Optic disc-centered · intraocular pressure 25 mmHg (pneumatic tonometry) · patient age: 46 years · Topcon TRC-NW400 — 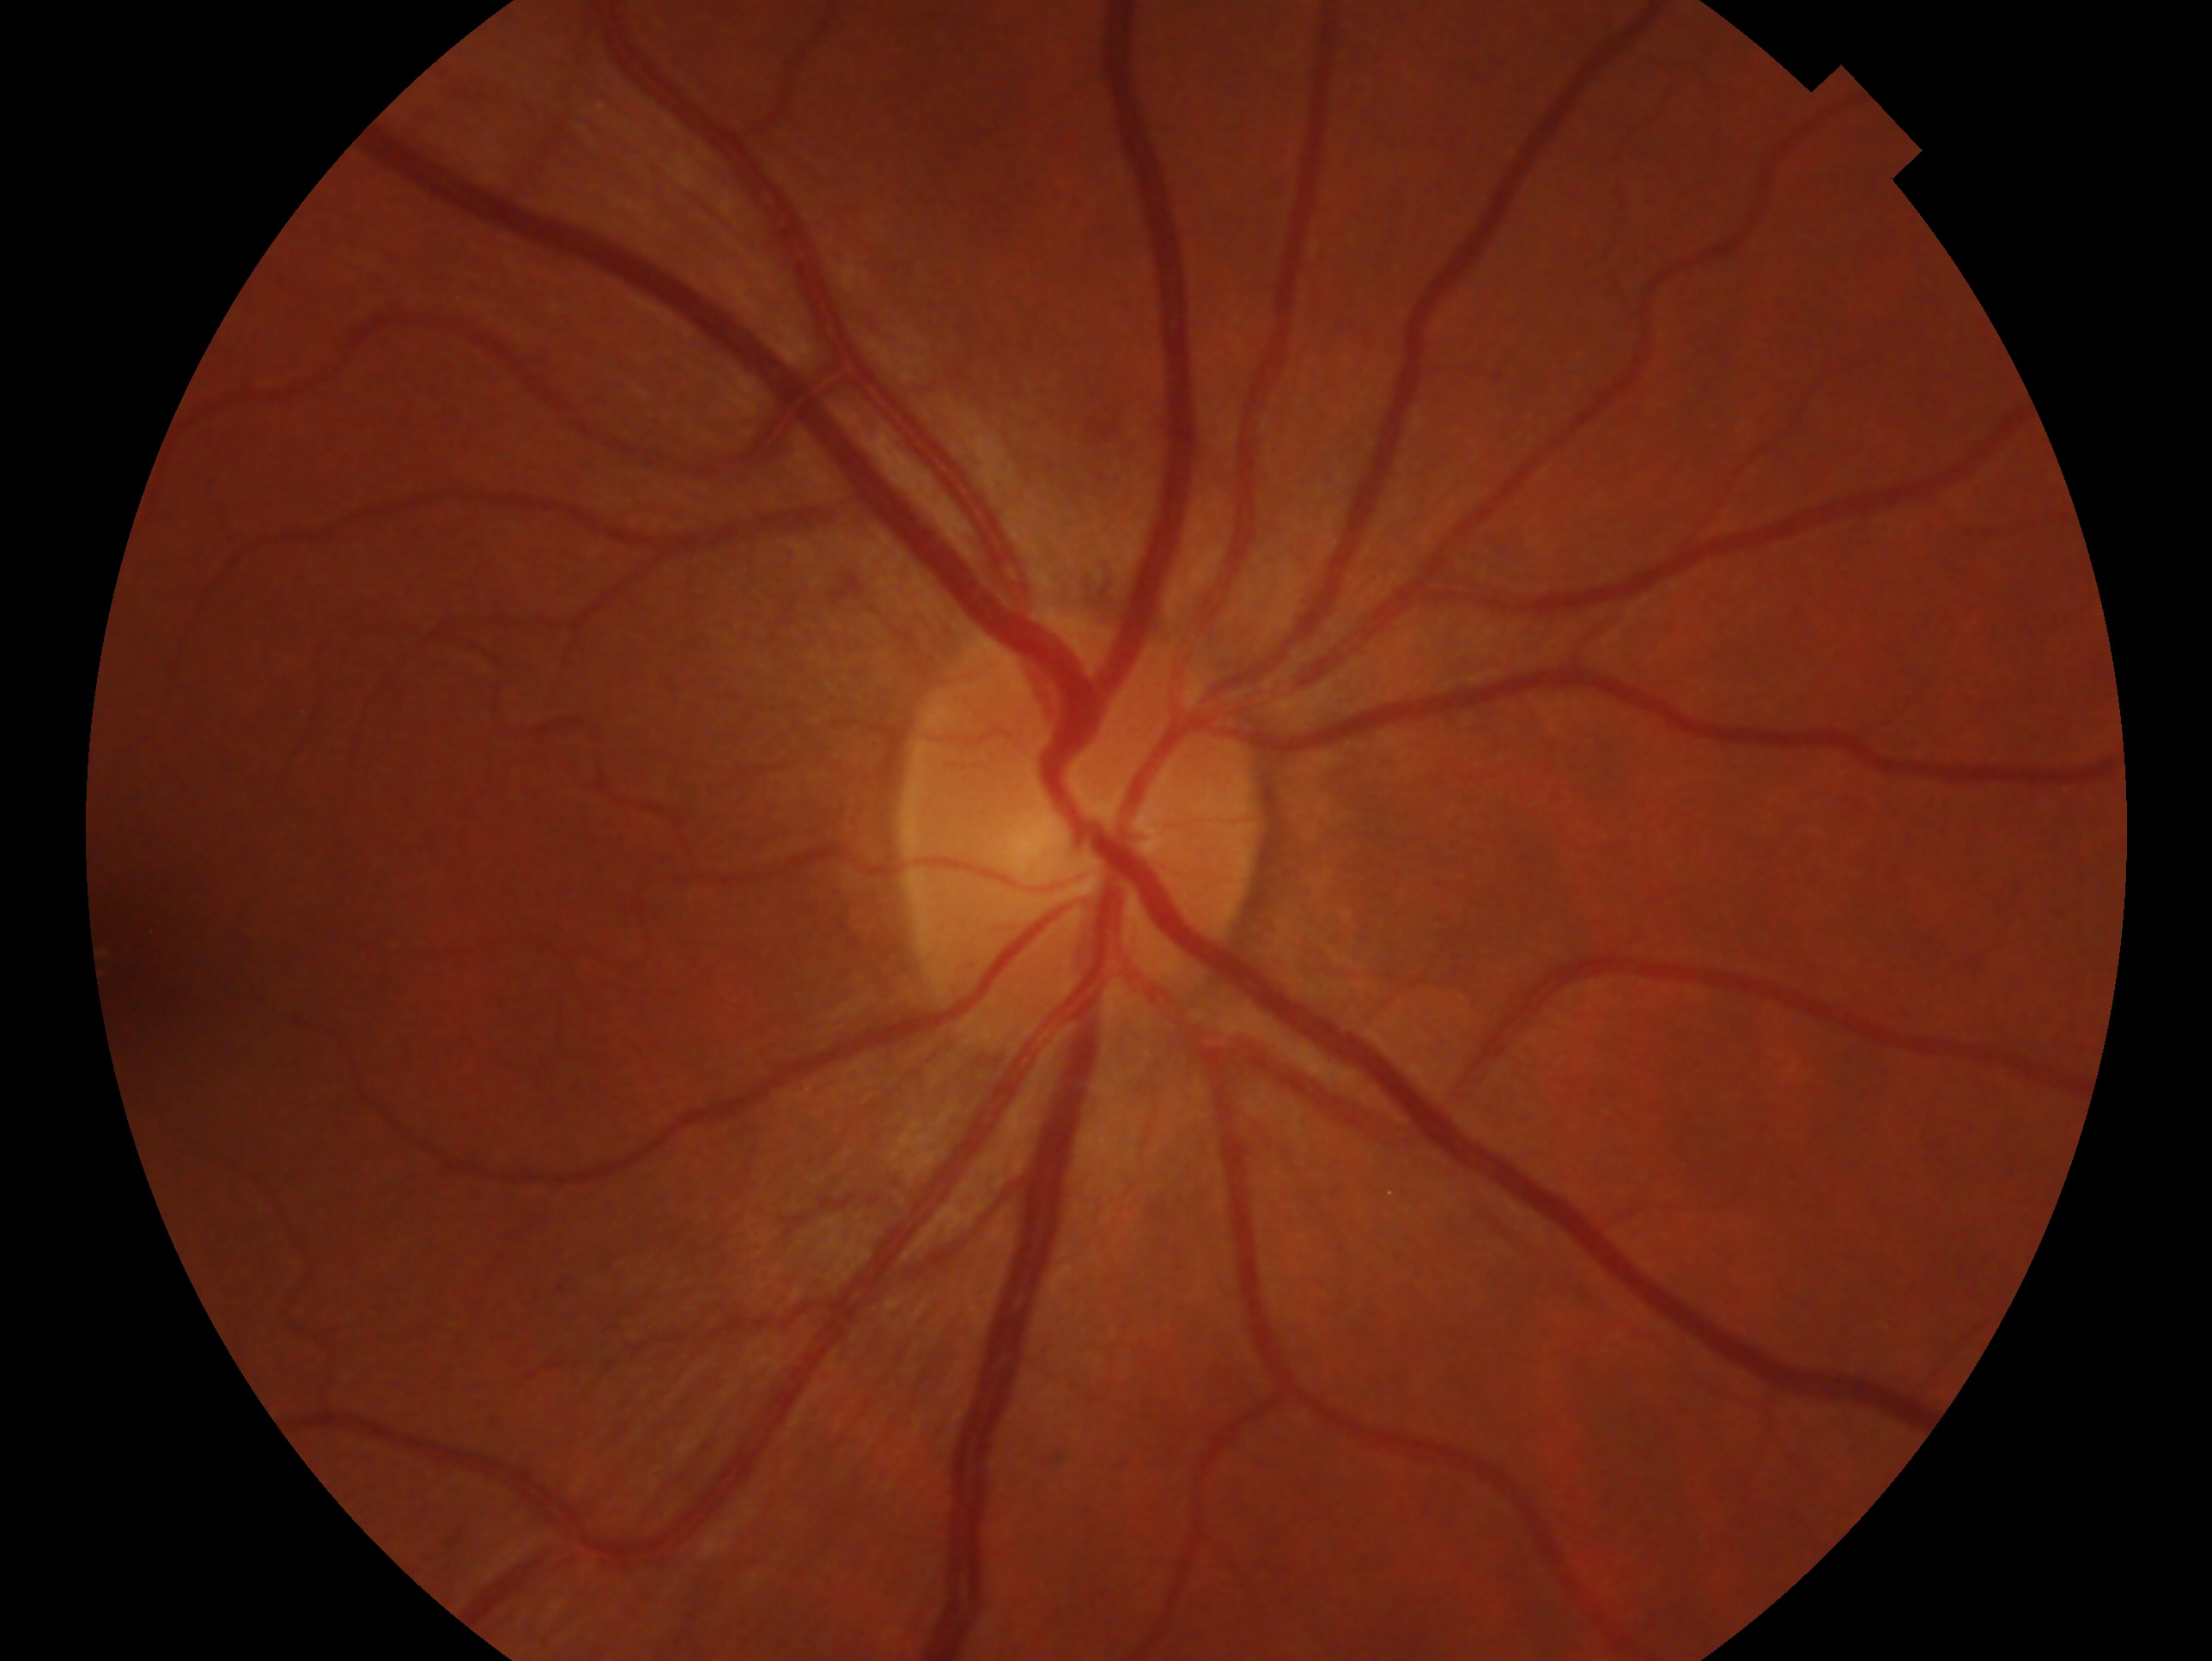

clinical classification: no signs of glaucoma
laterality: right eye